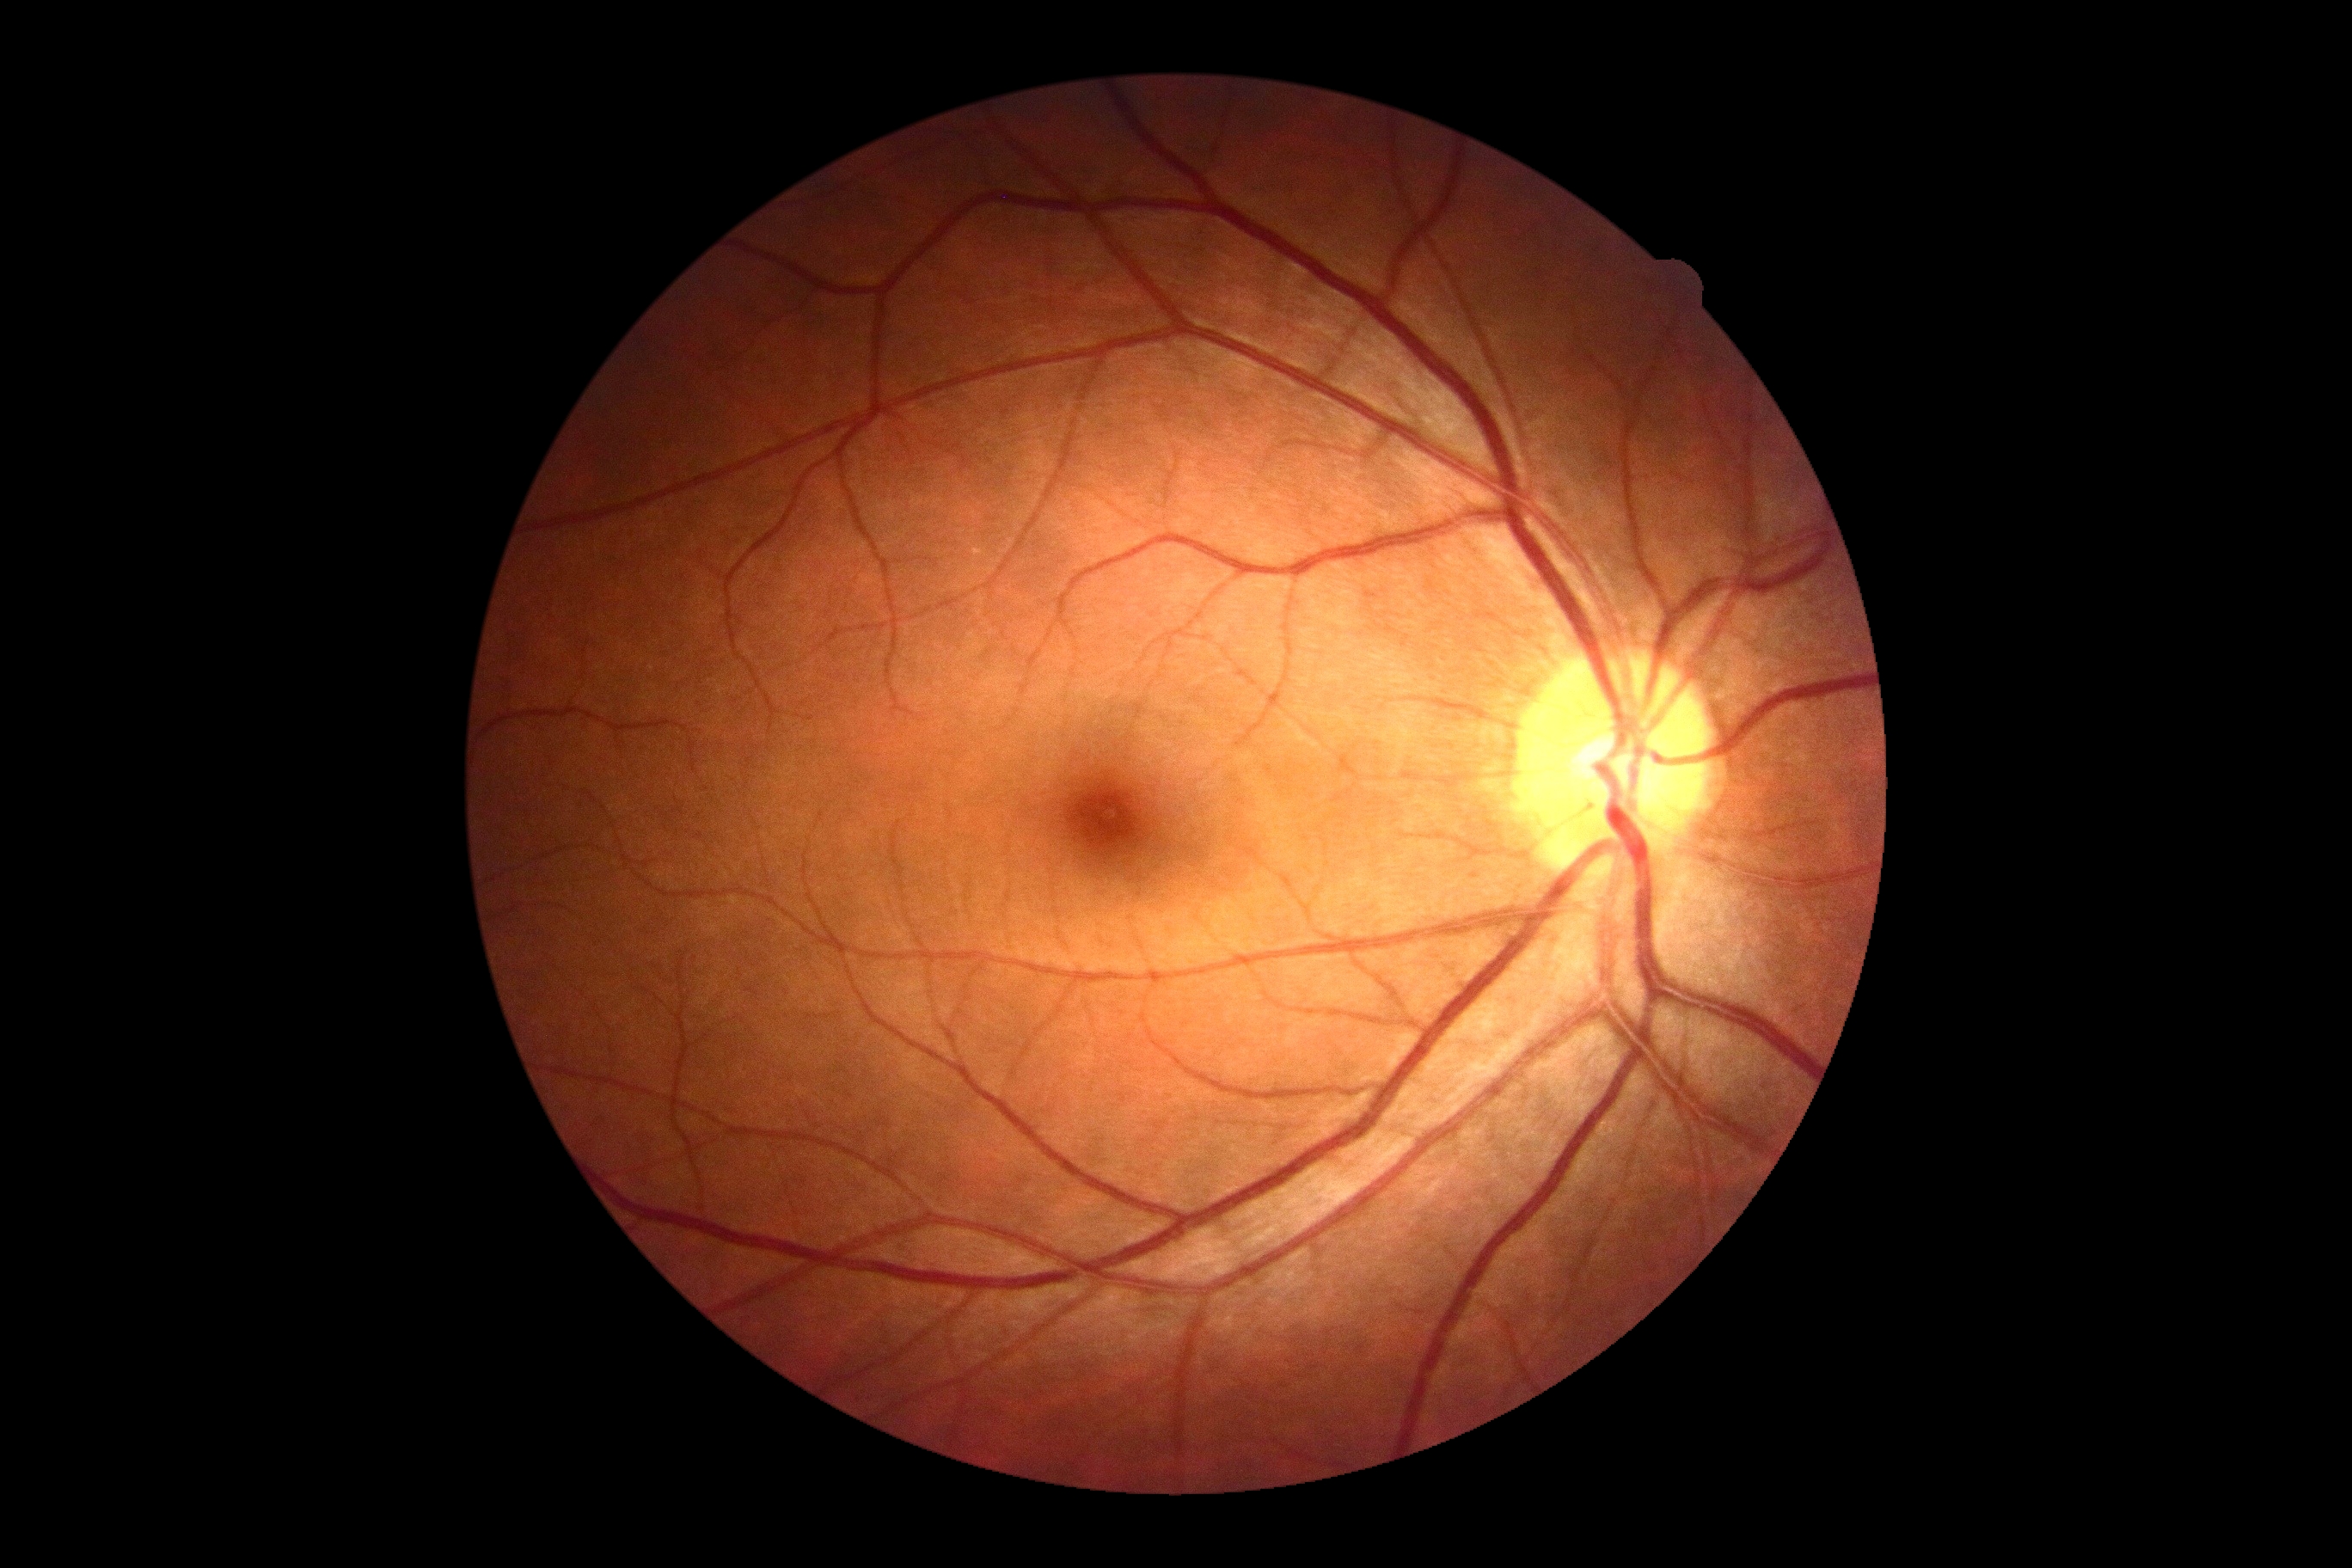
DR grade: 0/4.